2048x1536px.
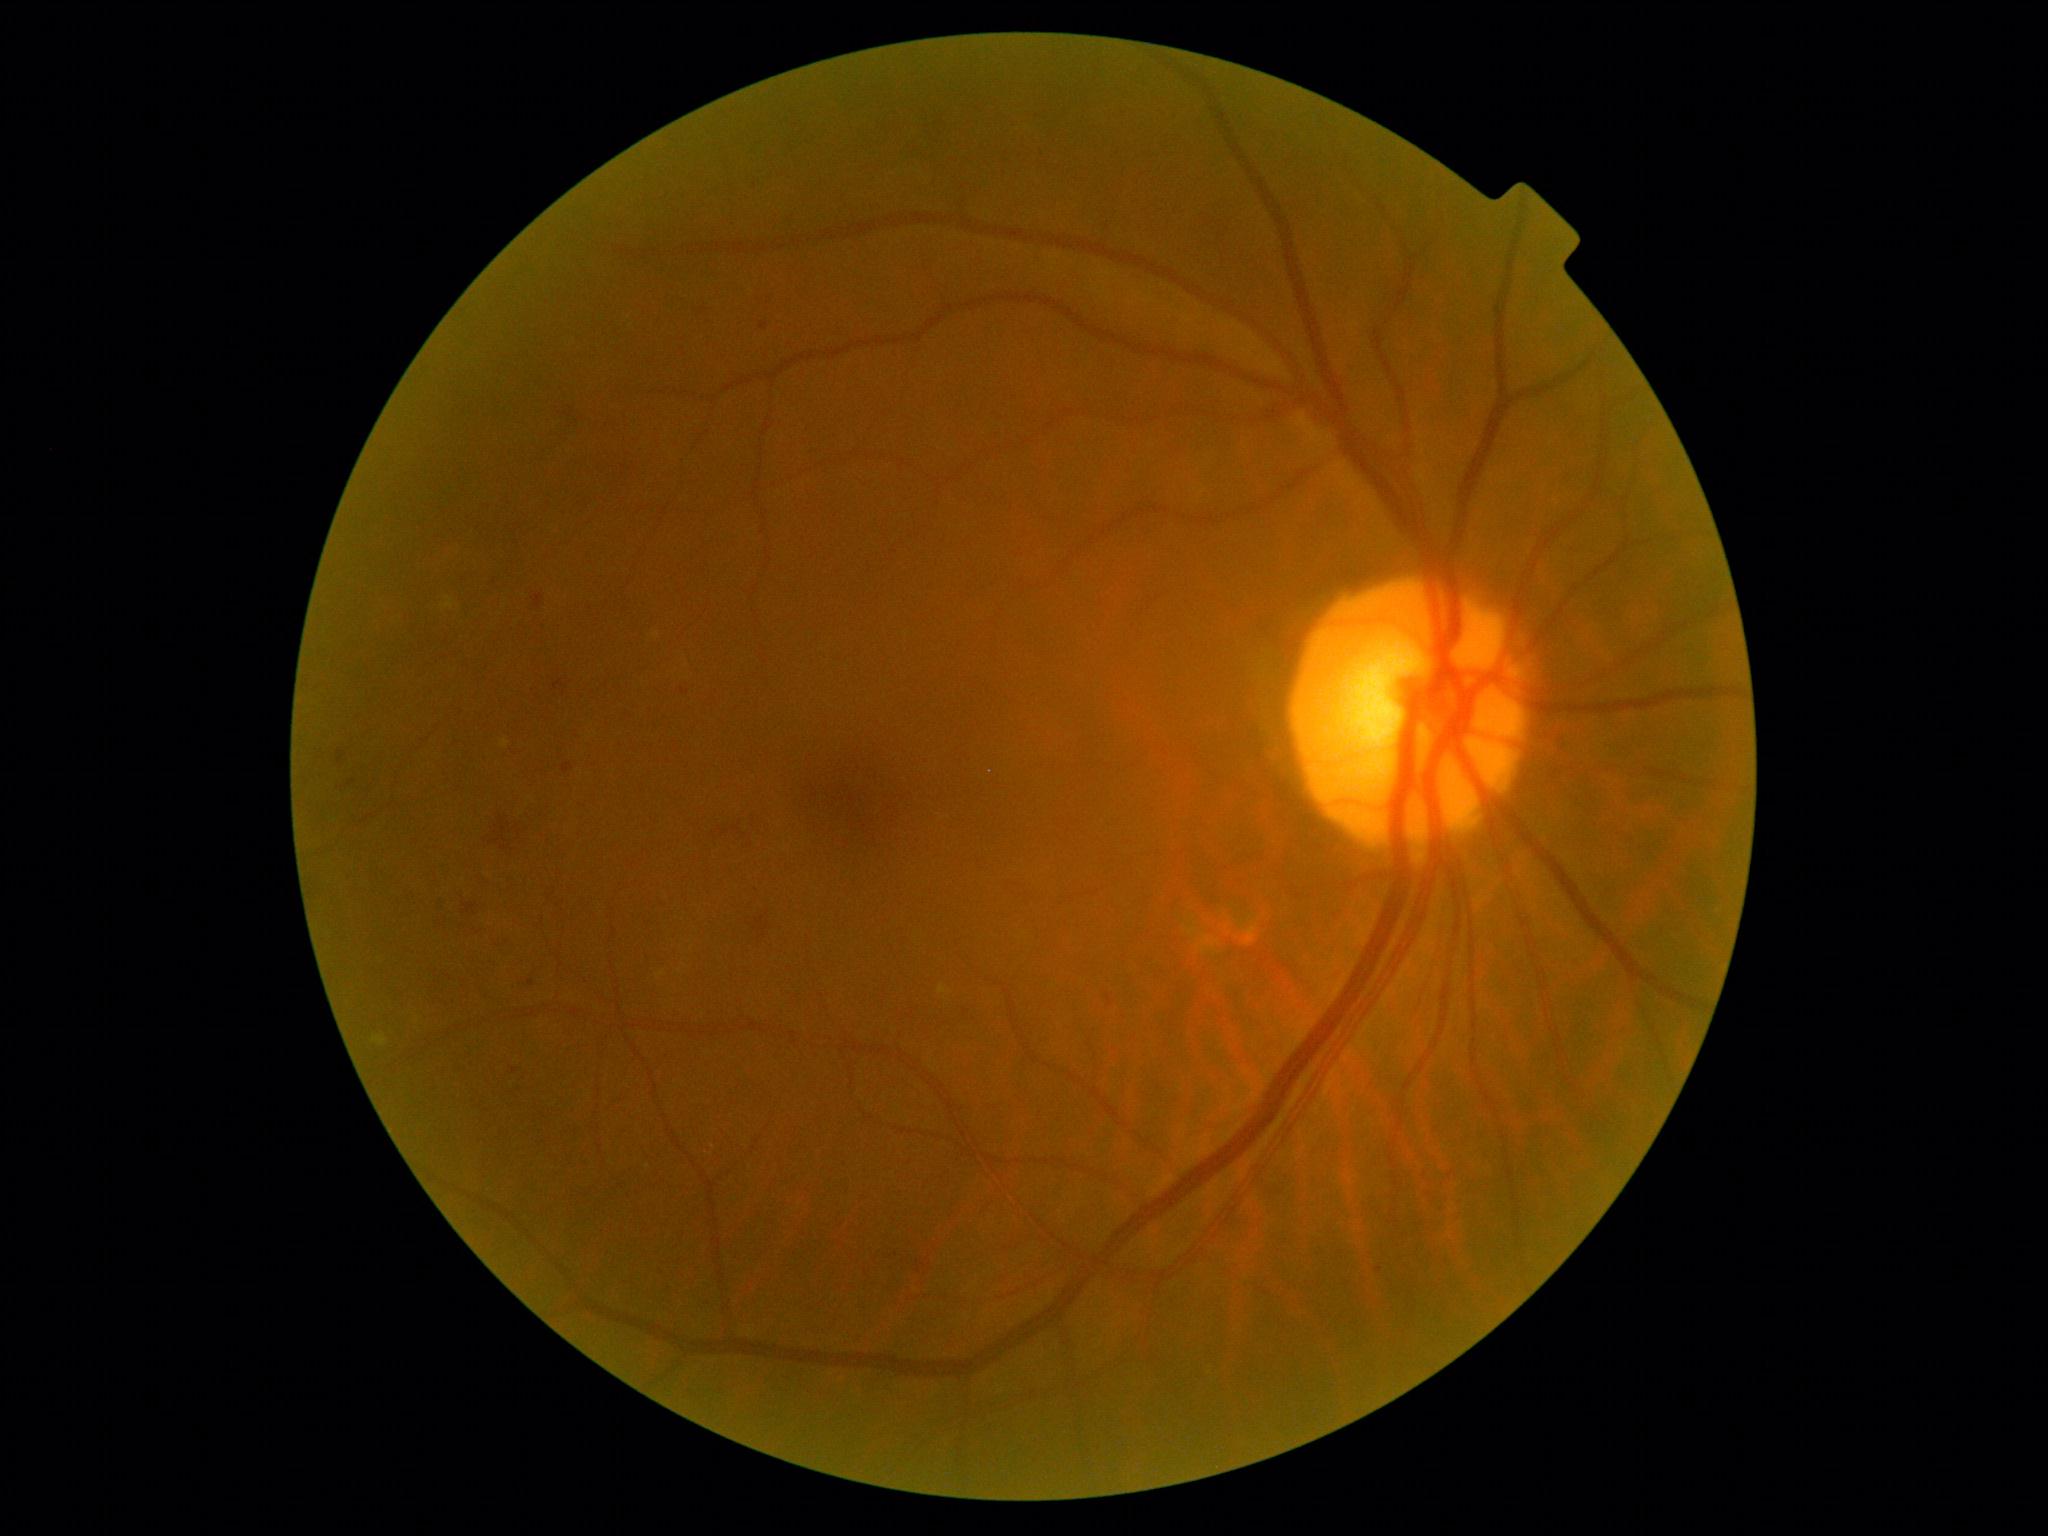 The retinopathy is classified as non-proliferative diabetic retinopathy.
DR is moderate NPDR (grade 2).